45° FOV · CFP
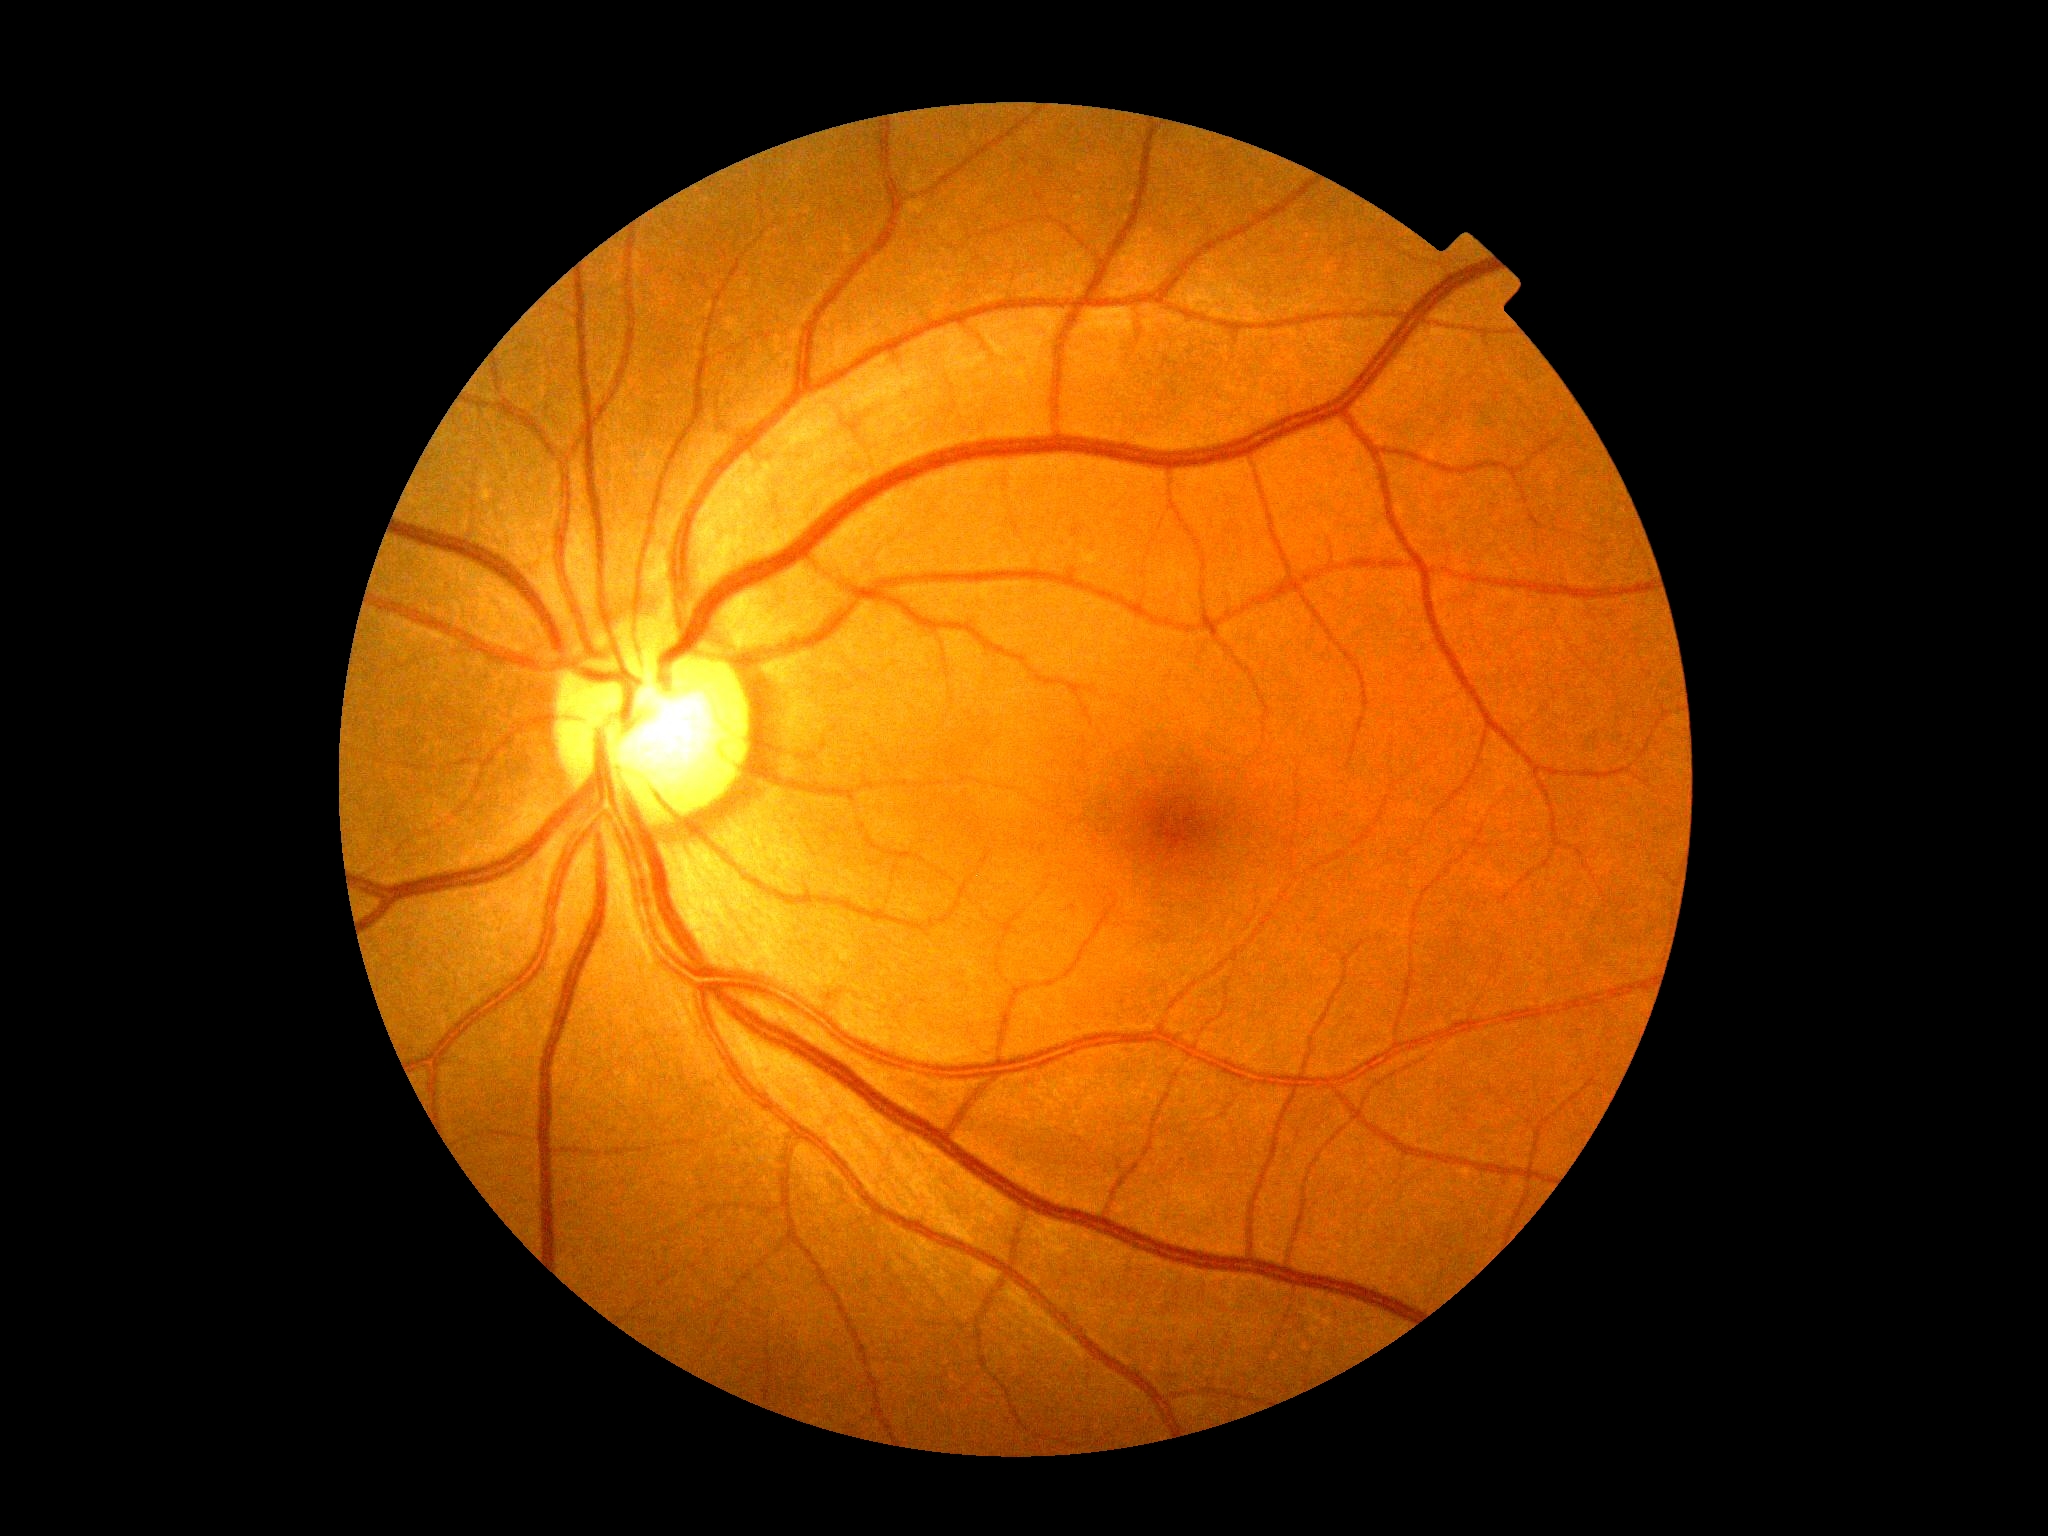 Retinopathy grade: 0.